Camera: NIDEK AFC-230. Retinal fundus photograph. No pharmacologic dilation. 848x848.
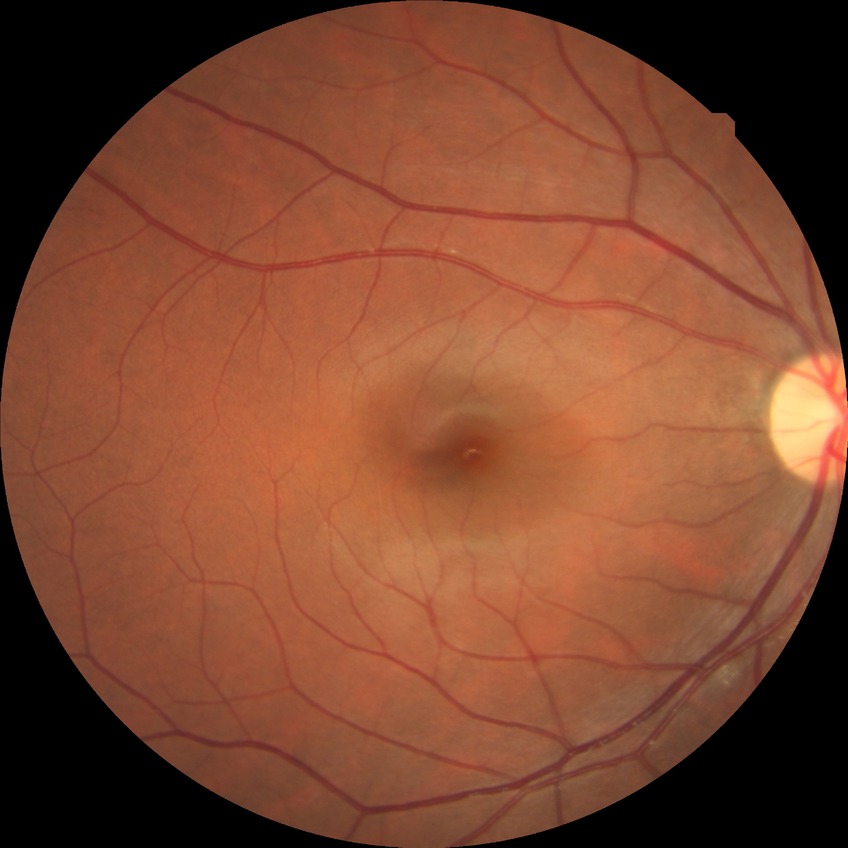

Diabetic retinopathy (DR) is NDR (no diabetic retinopathy).